200-degree field of view. Wide-field retinal mosaic image: 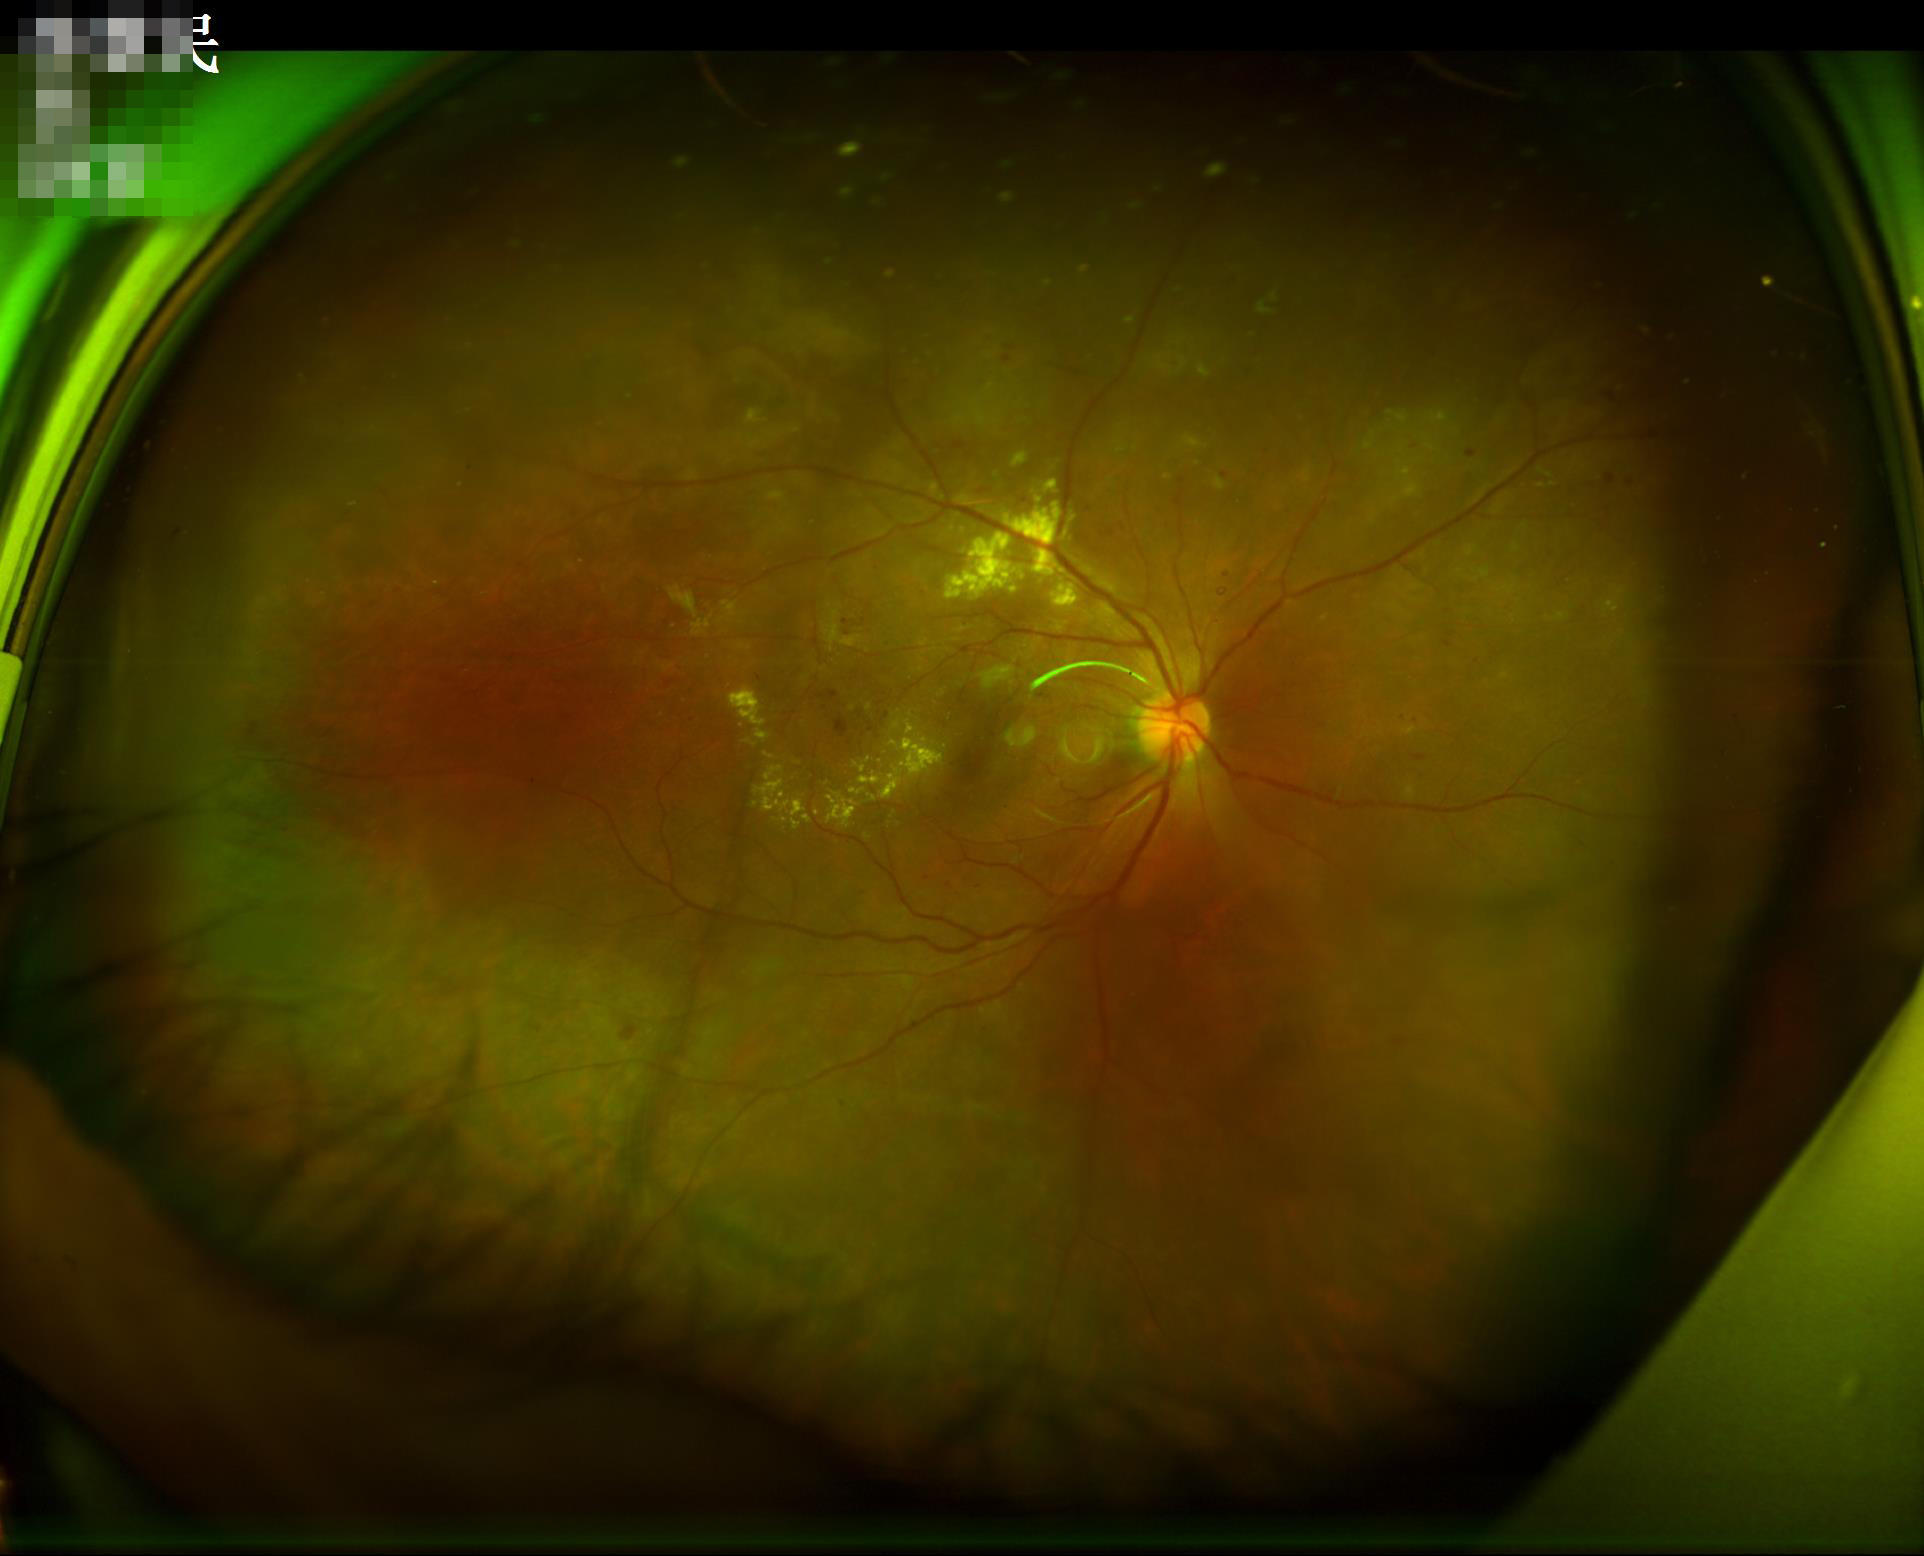
Contrast = adequate | Illumination = uneven | Overall image quality = good | Focus = sharp.